NIDEK AFC-230 fundus camera · without pupil dilation
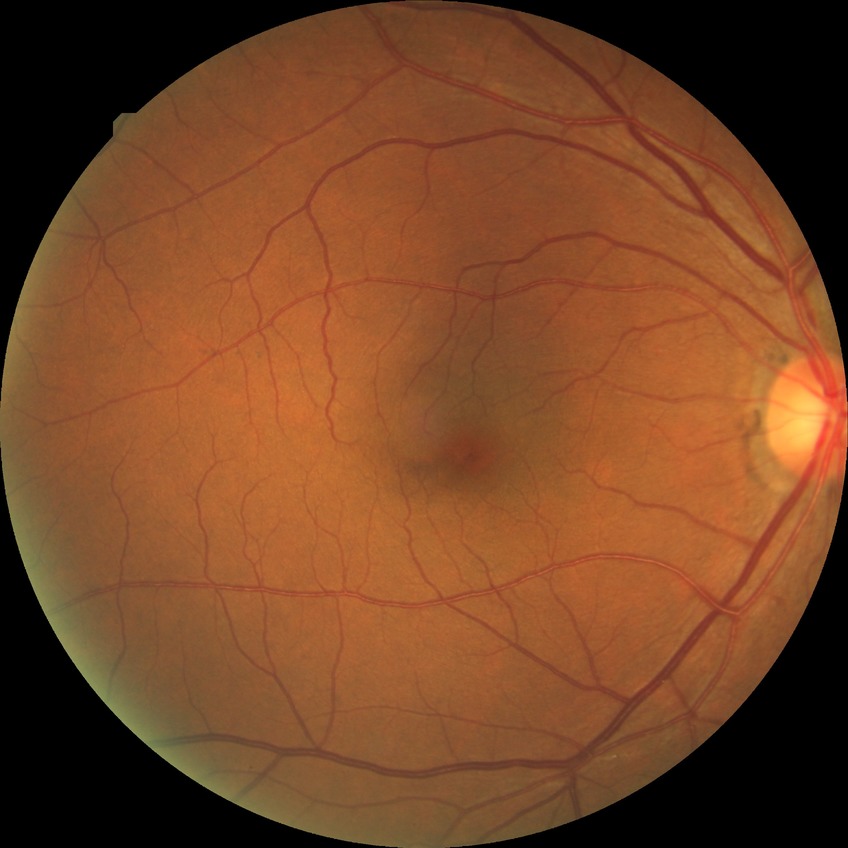 Modified Davis grading is no diabetic retinopathy.